Wide-field fundus photograph of an infant — 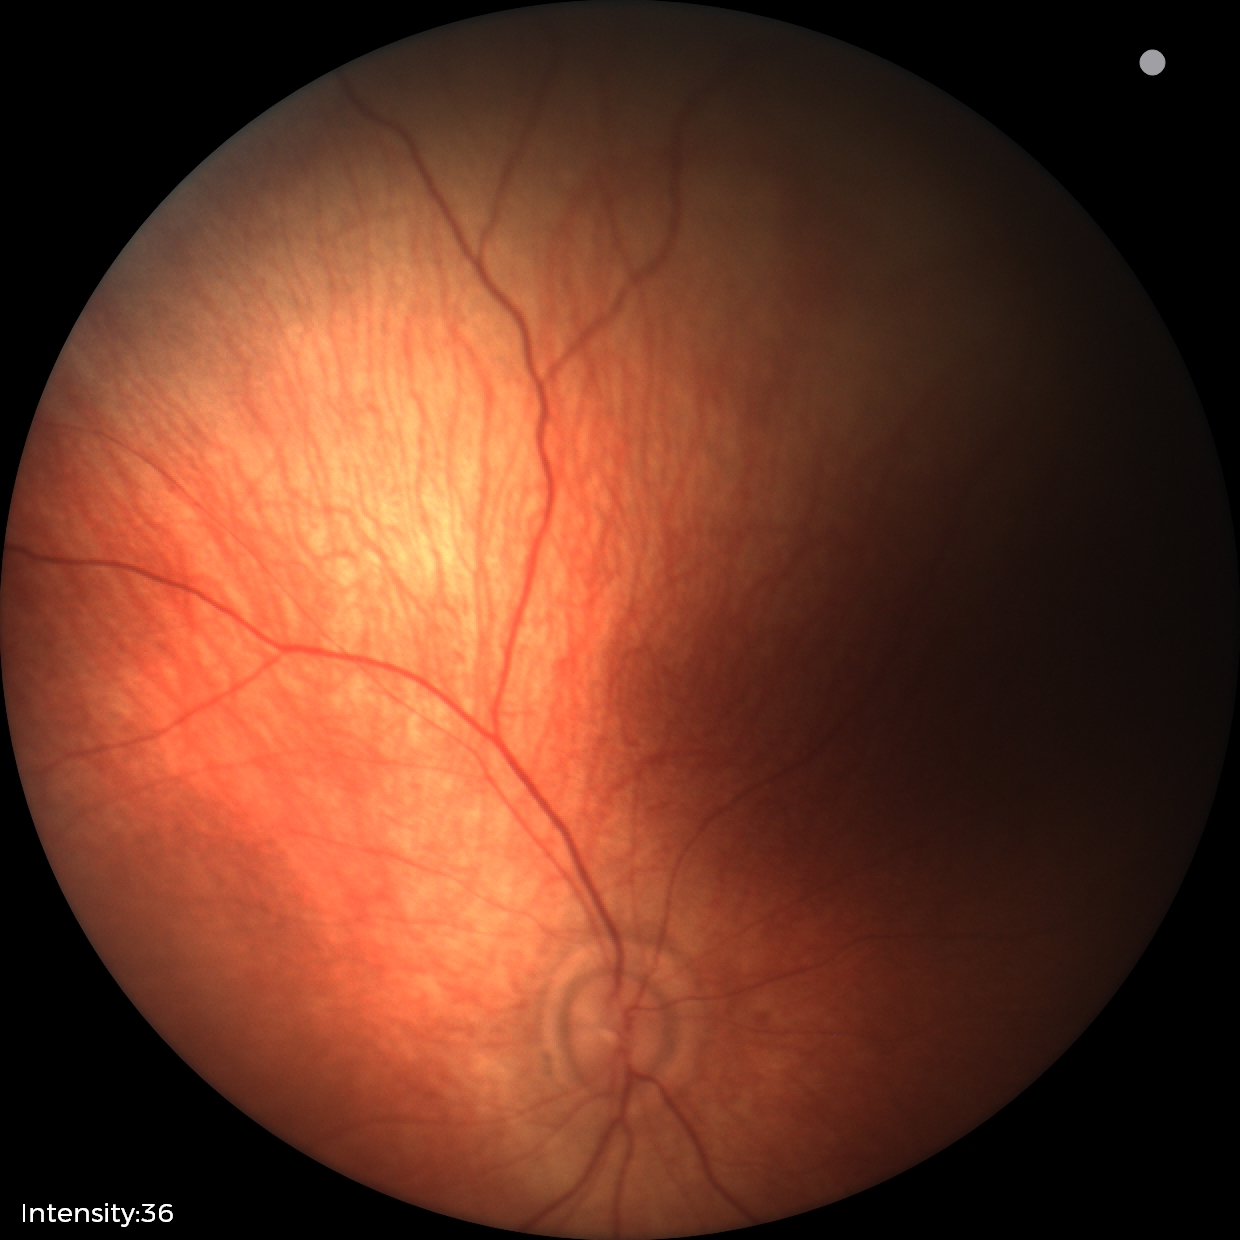

Examination with physiological retinal findings.